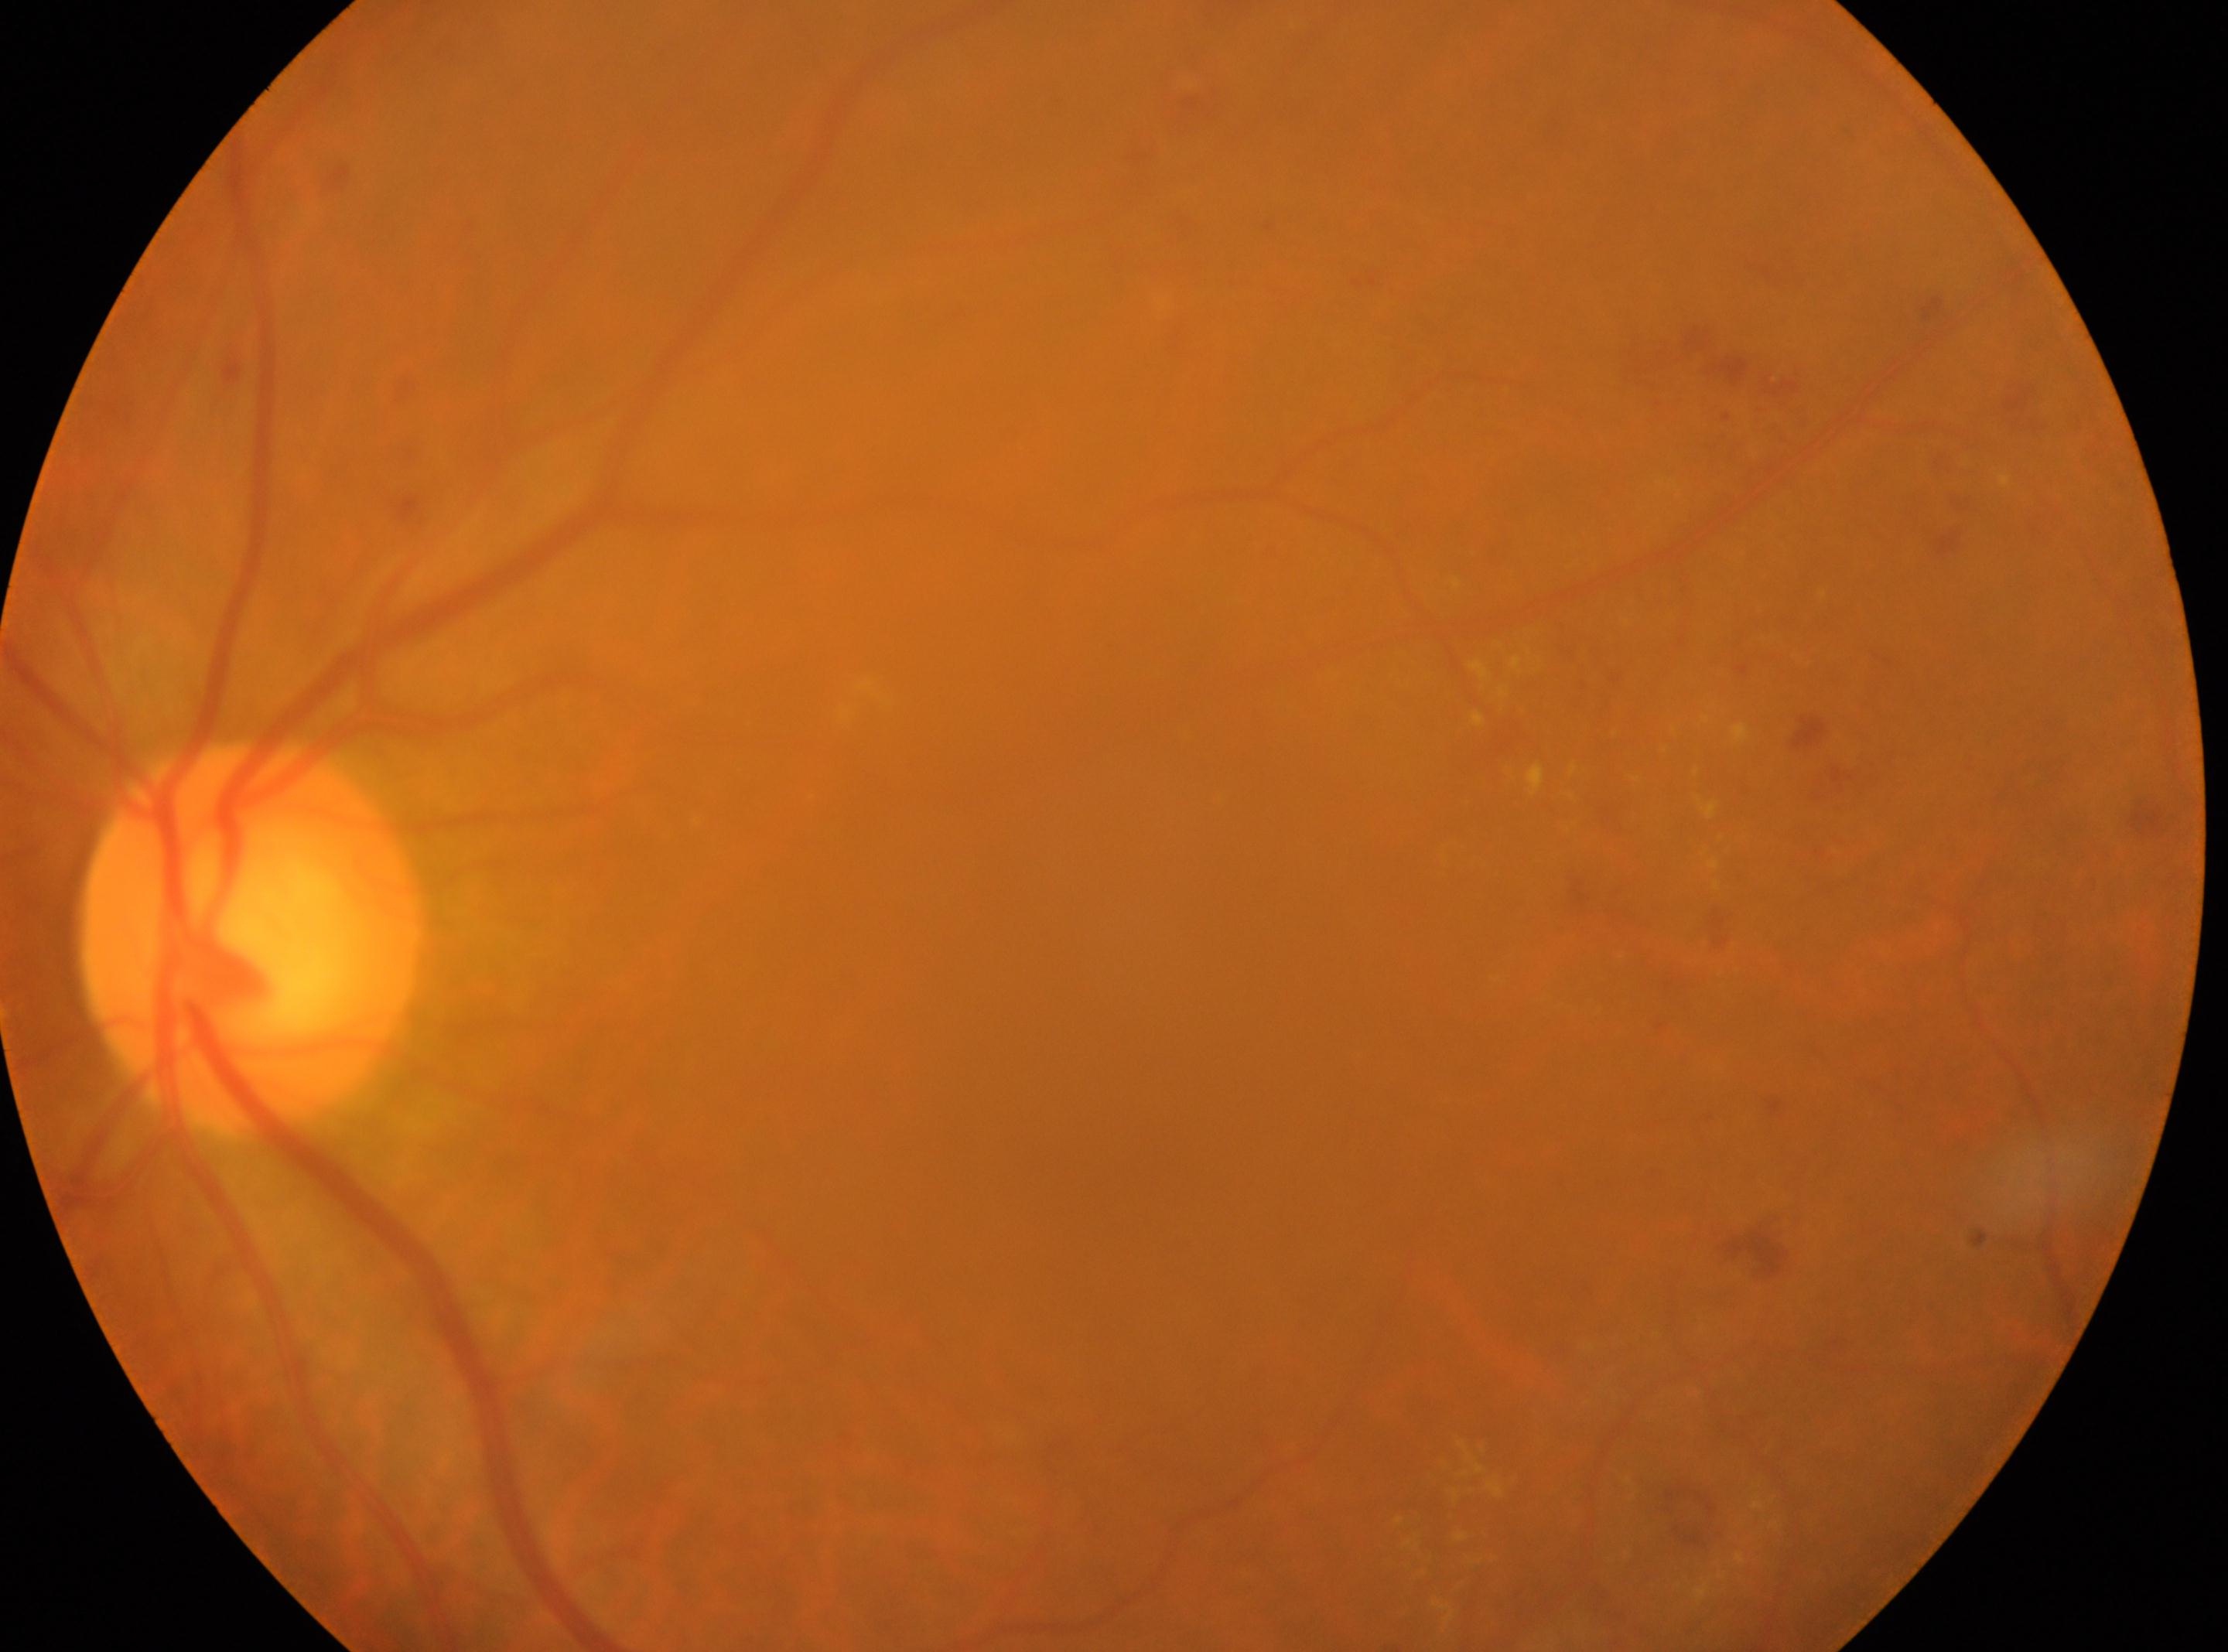
Findings:
* DR · grade 2
* fovea center · (1131, 1101)
* laterality · left eye
* optic disk · (251, 937)
* DR class · non-proliferative diabetic retinopathy